45-degree field of view: 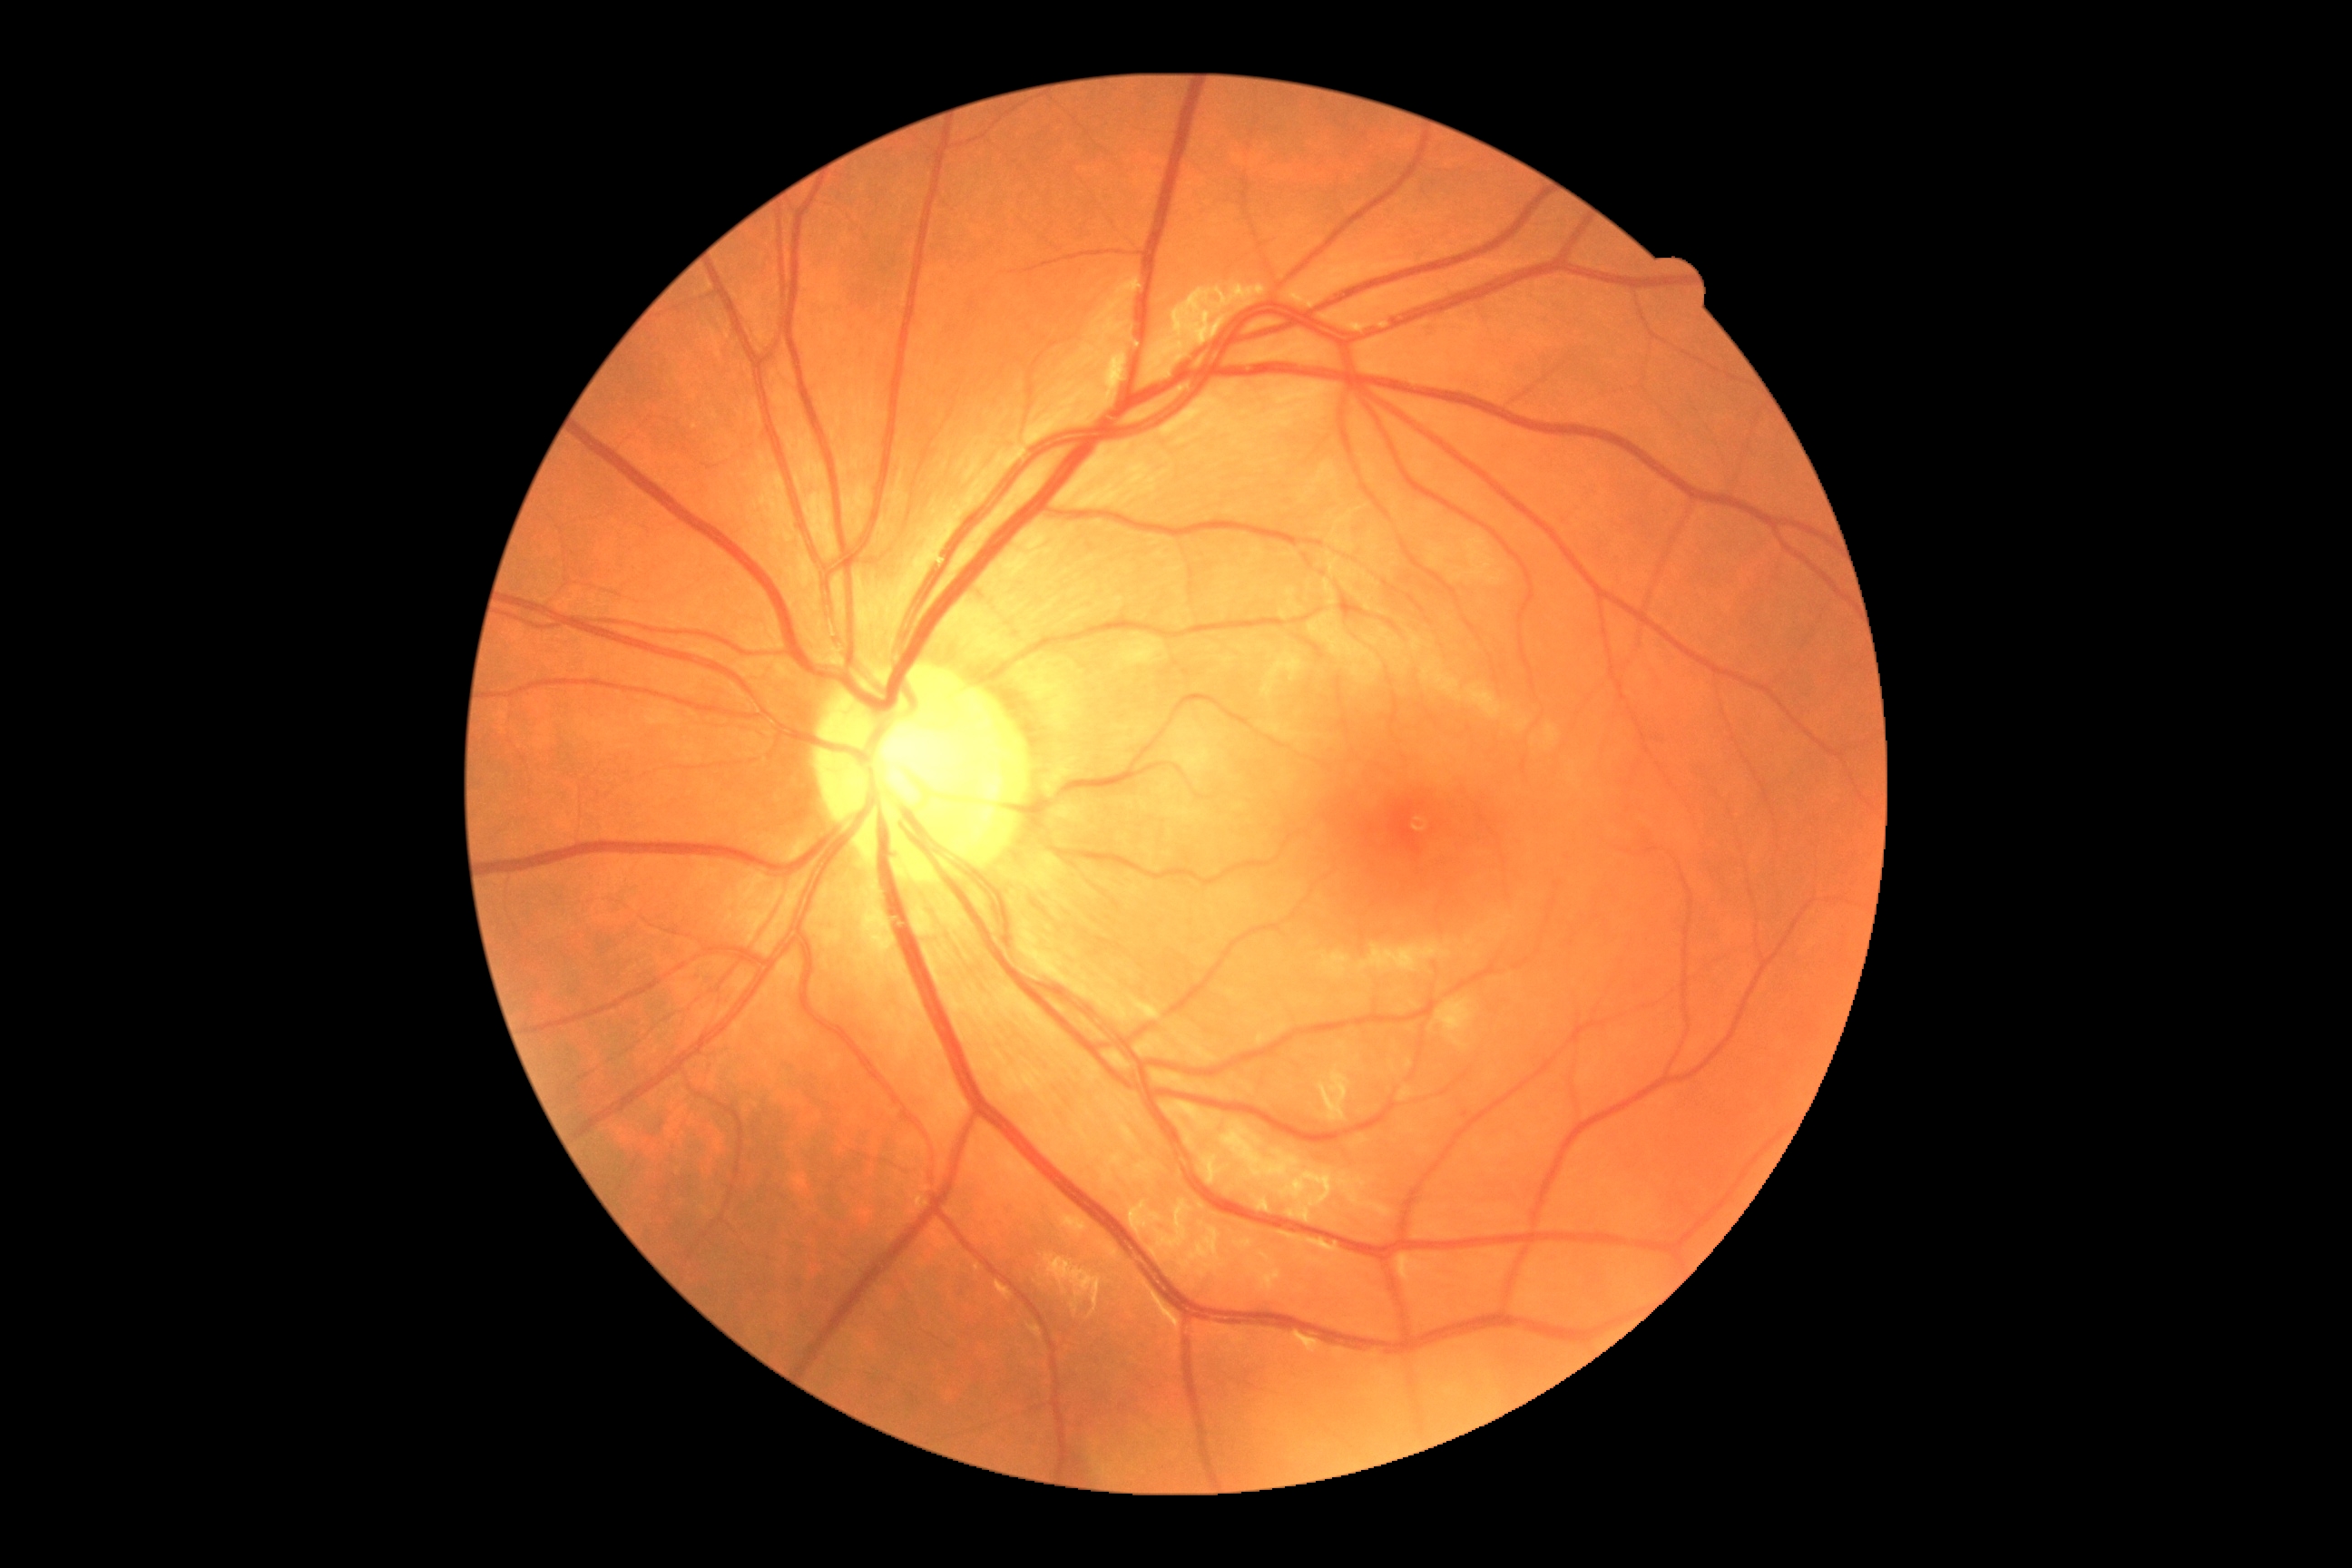 diabetic retinopathy (DR): grade 0 (no apparent retinopathy).